Wide-field contact fundus photograph of an infant — 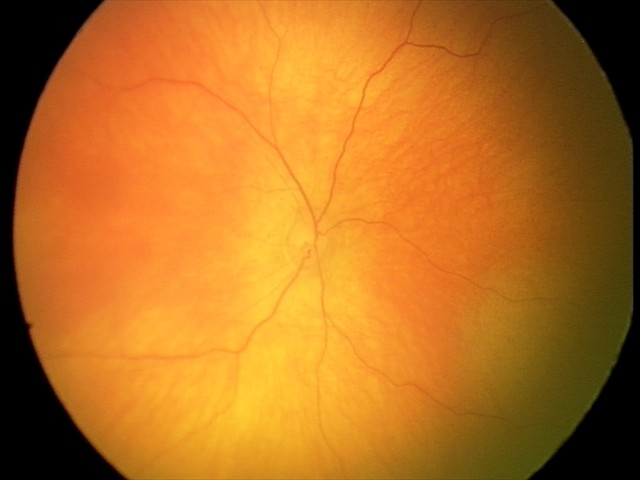 Physiological retinal appearance for postconceptual age.